Fundus photo
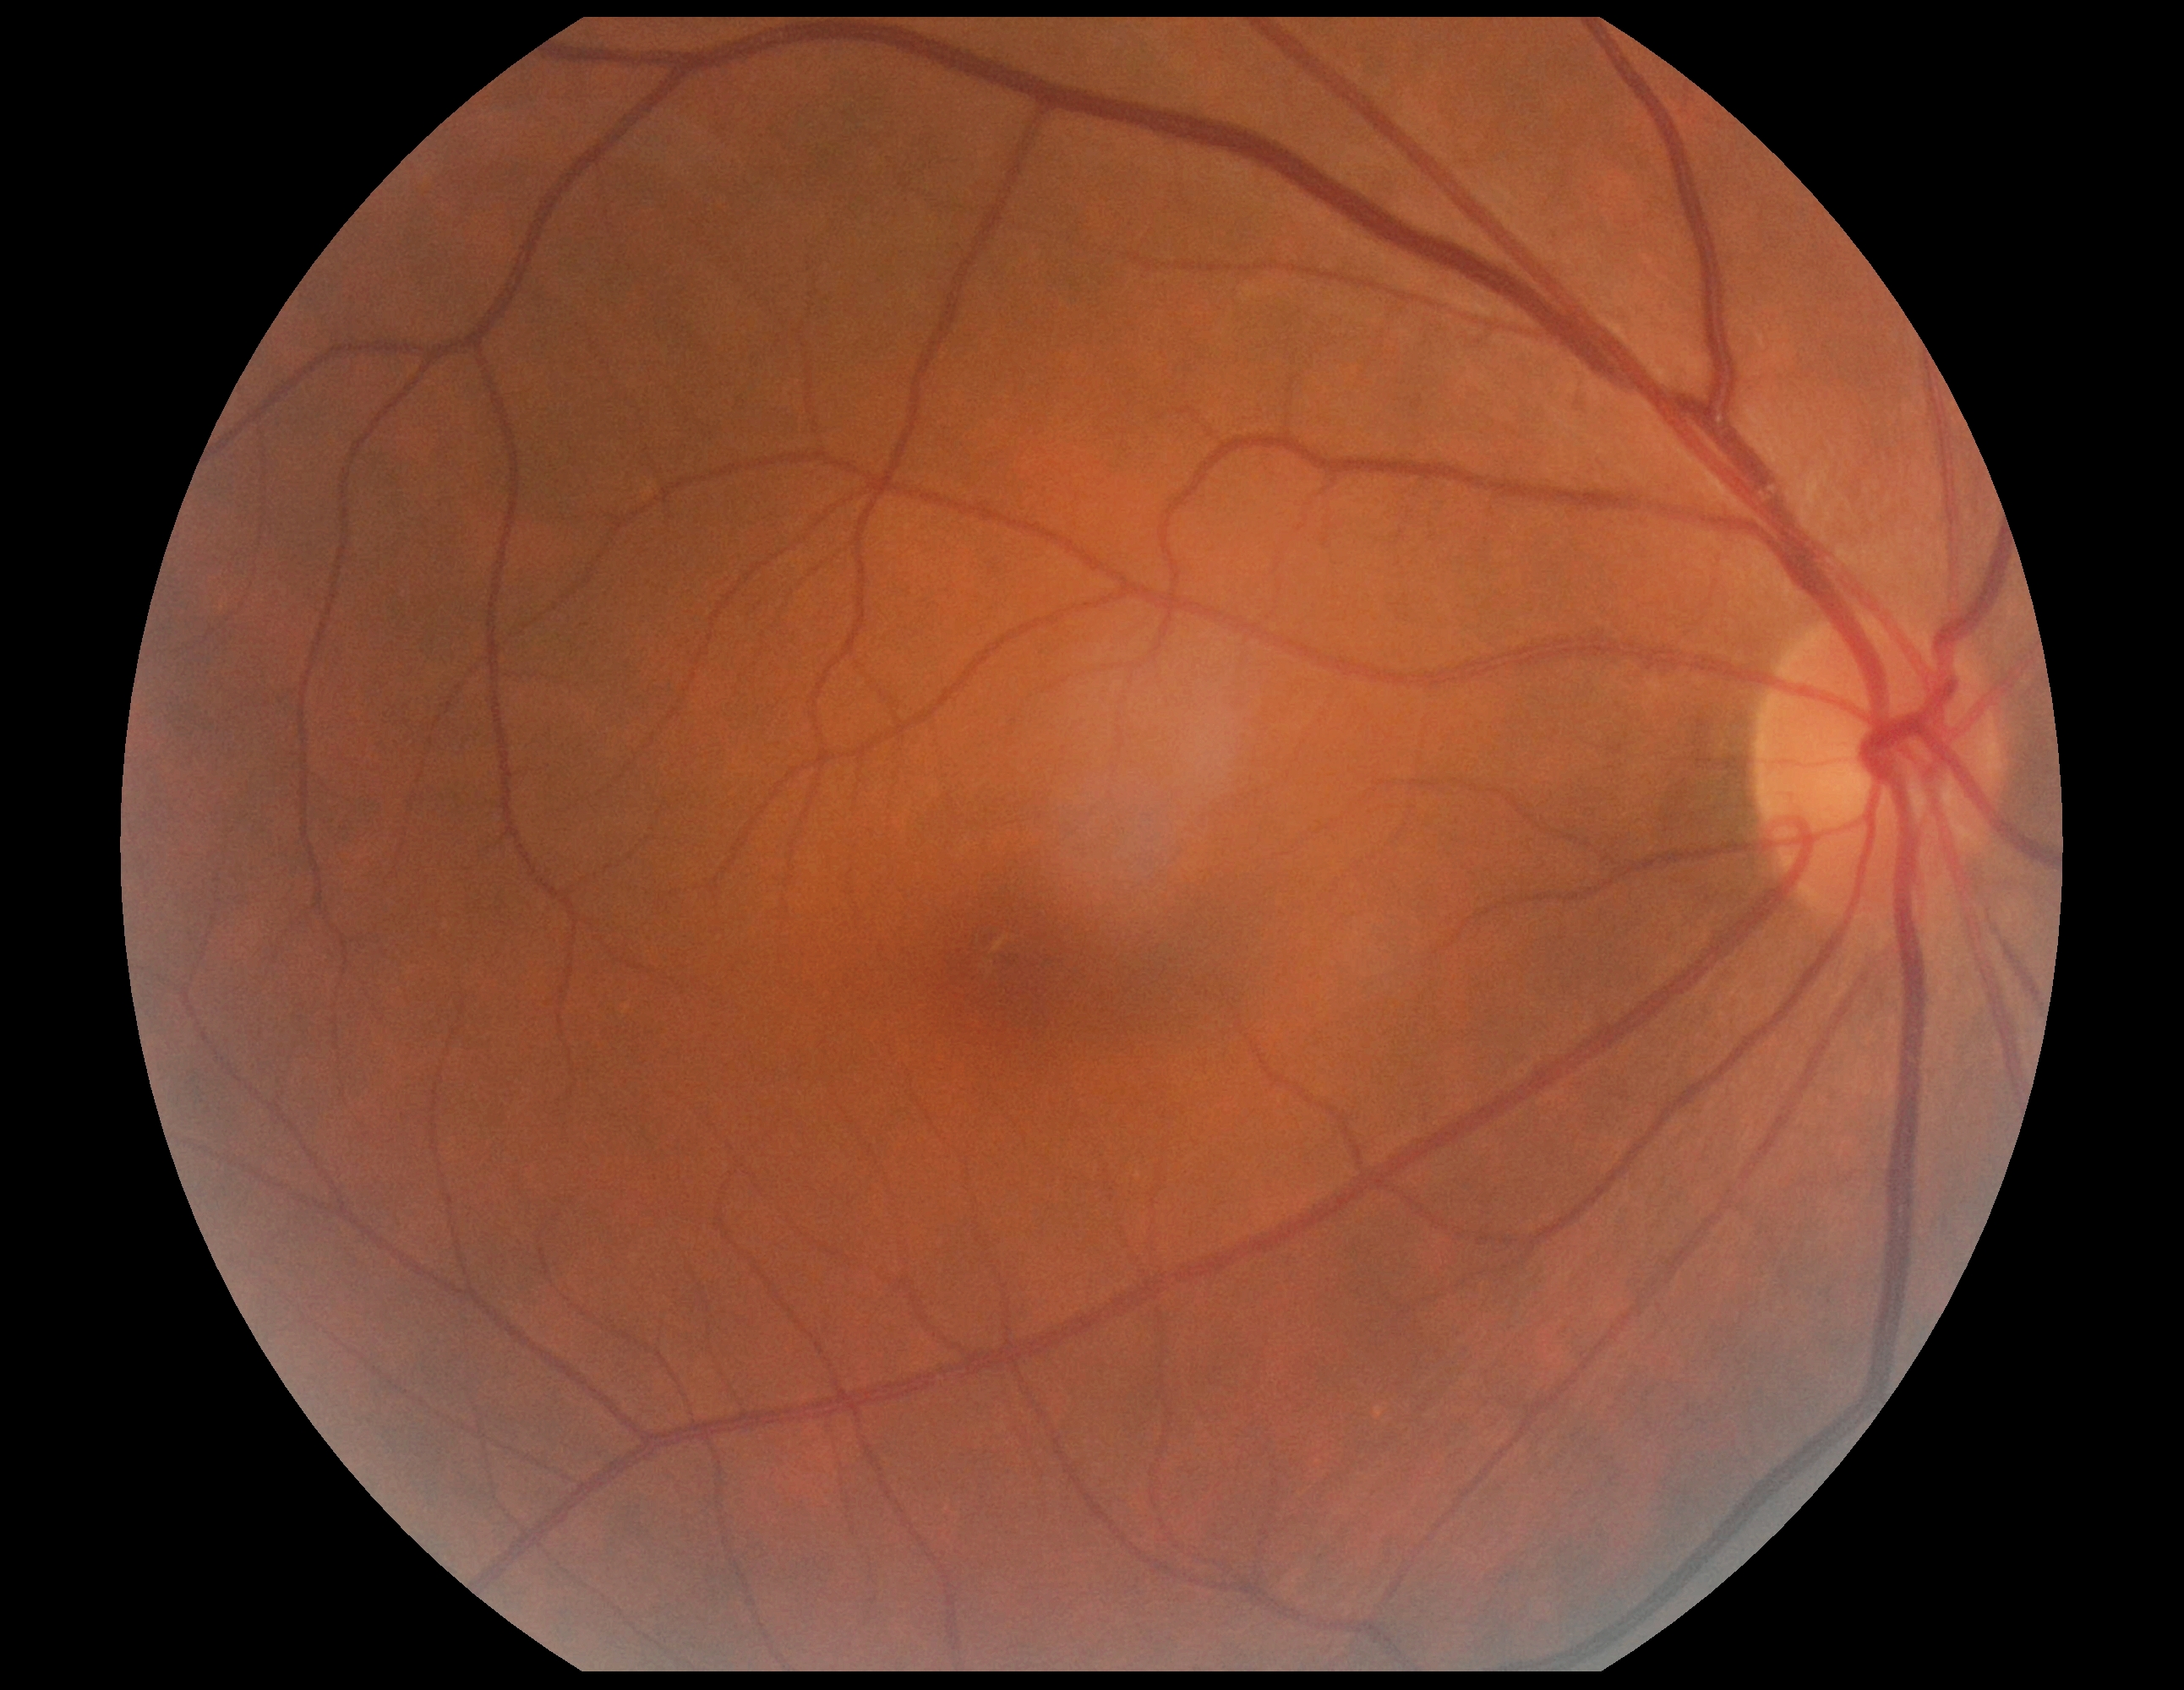
  dr_grade: no apparent diabetic retinopathy (grade 0)